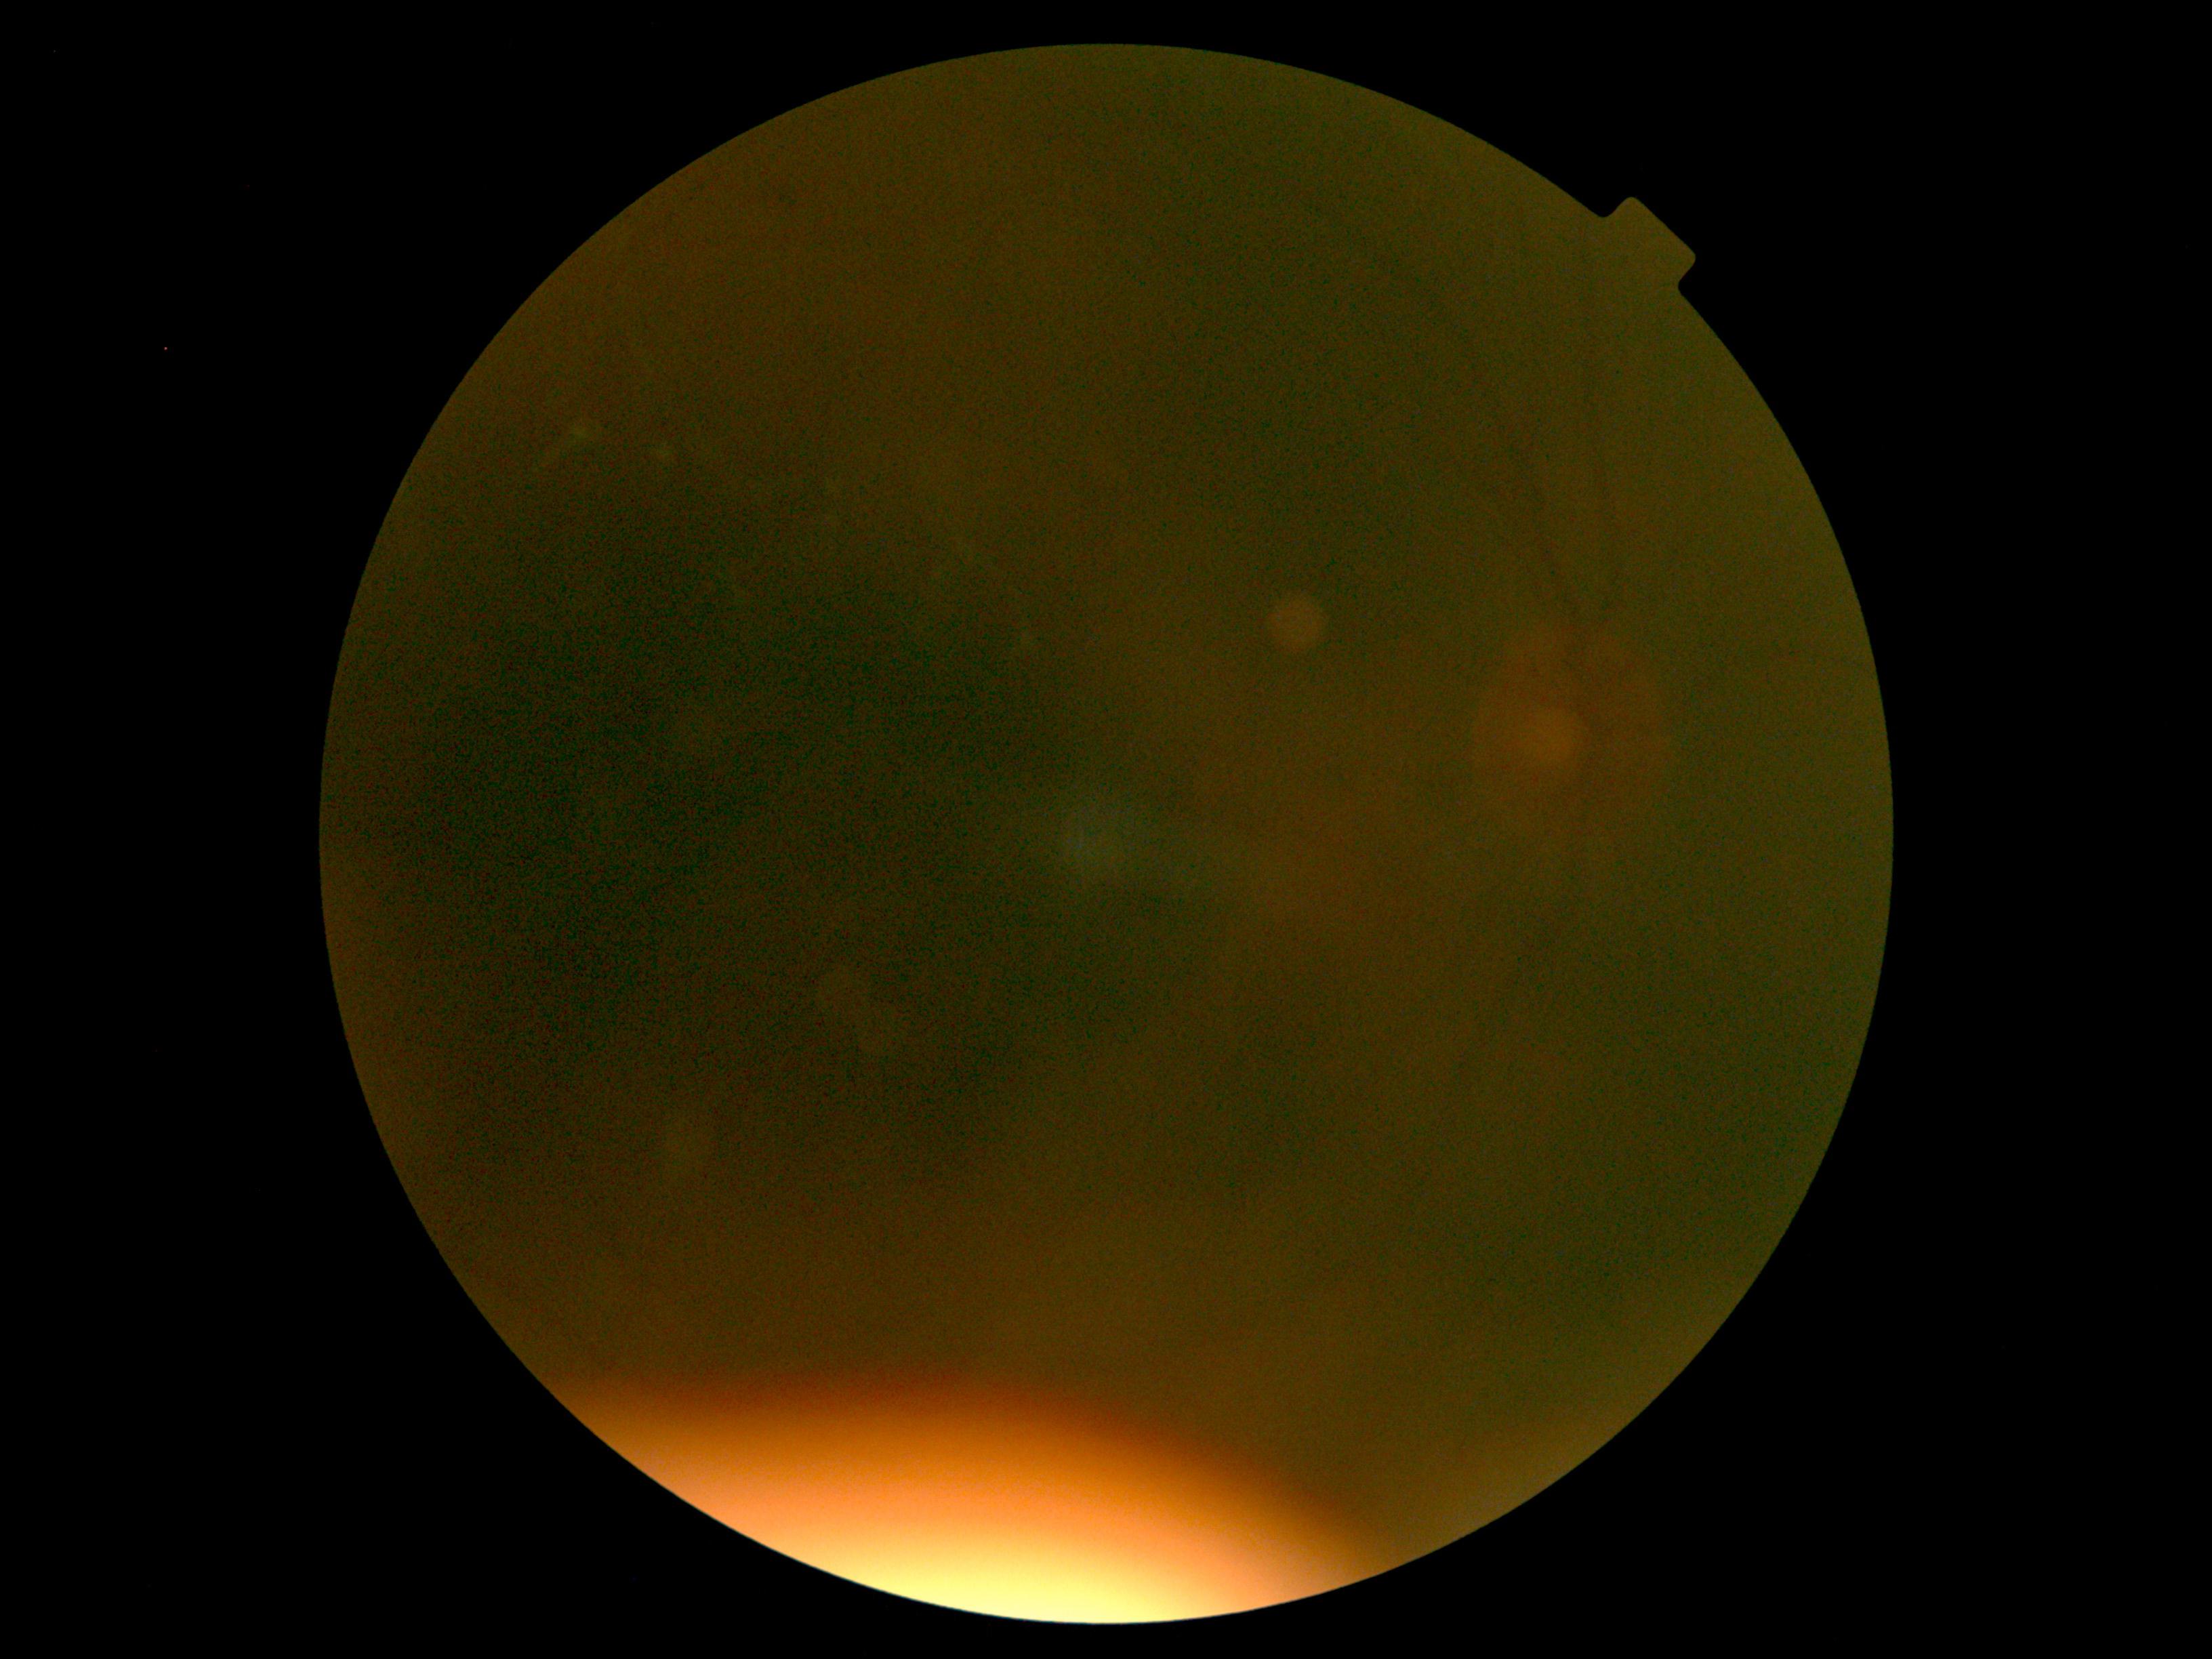

diabetic retinopathy severity: ungradable due to poor image quality | image quality: too poor for DR grading.